Fundus photo, 50-degree field of view:
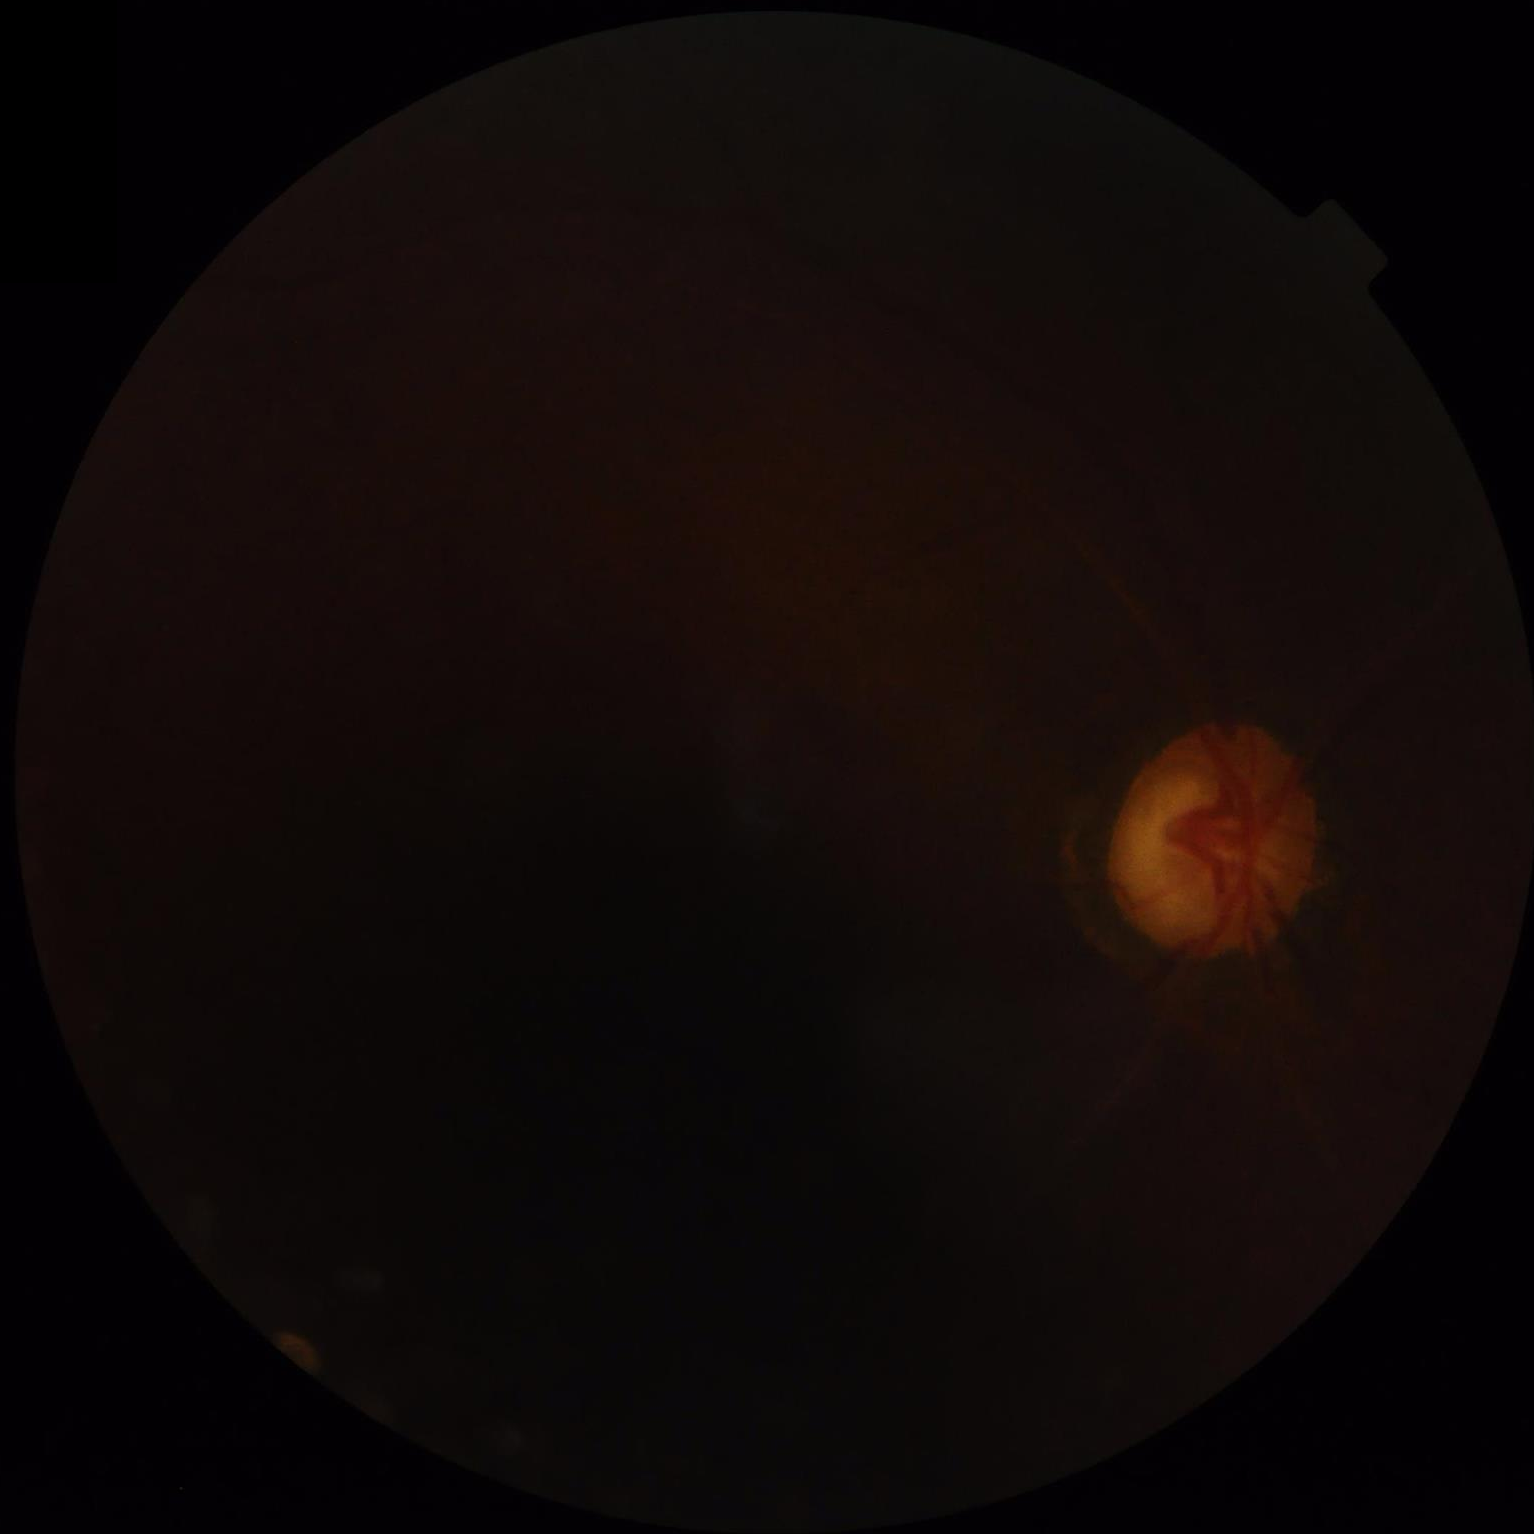

Quality assessment:
- contrast: poor
- overall: poor
- illumination/color: suboptimal
- clarity: out of focus